Posterior pole field covering the optic disc and macula. Captured after pupil dilation: 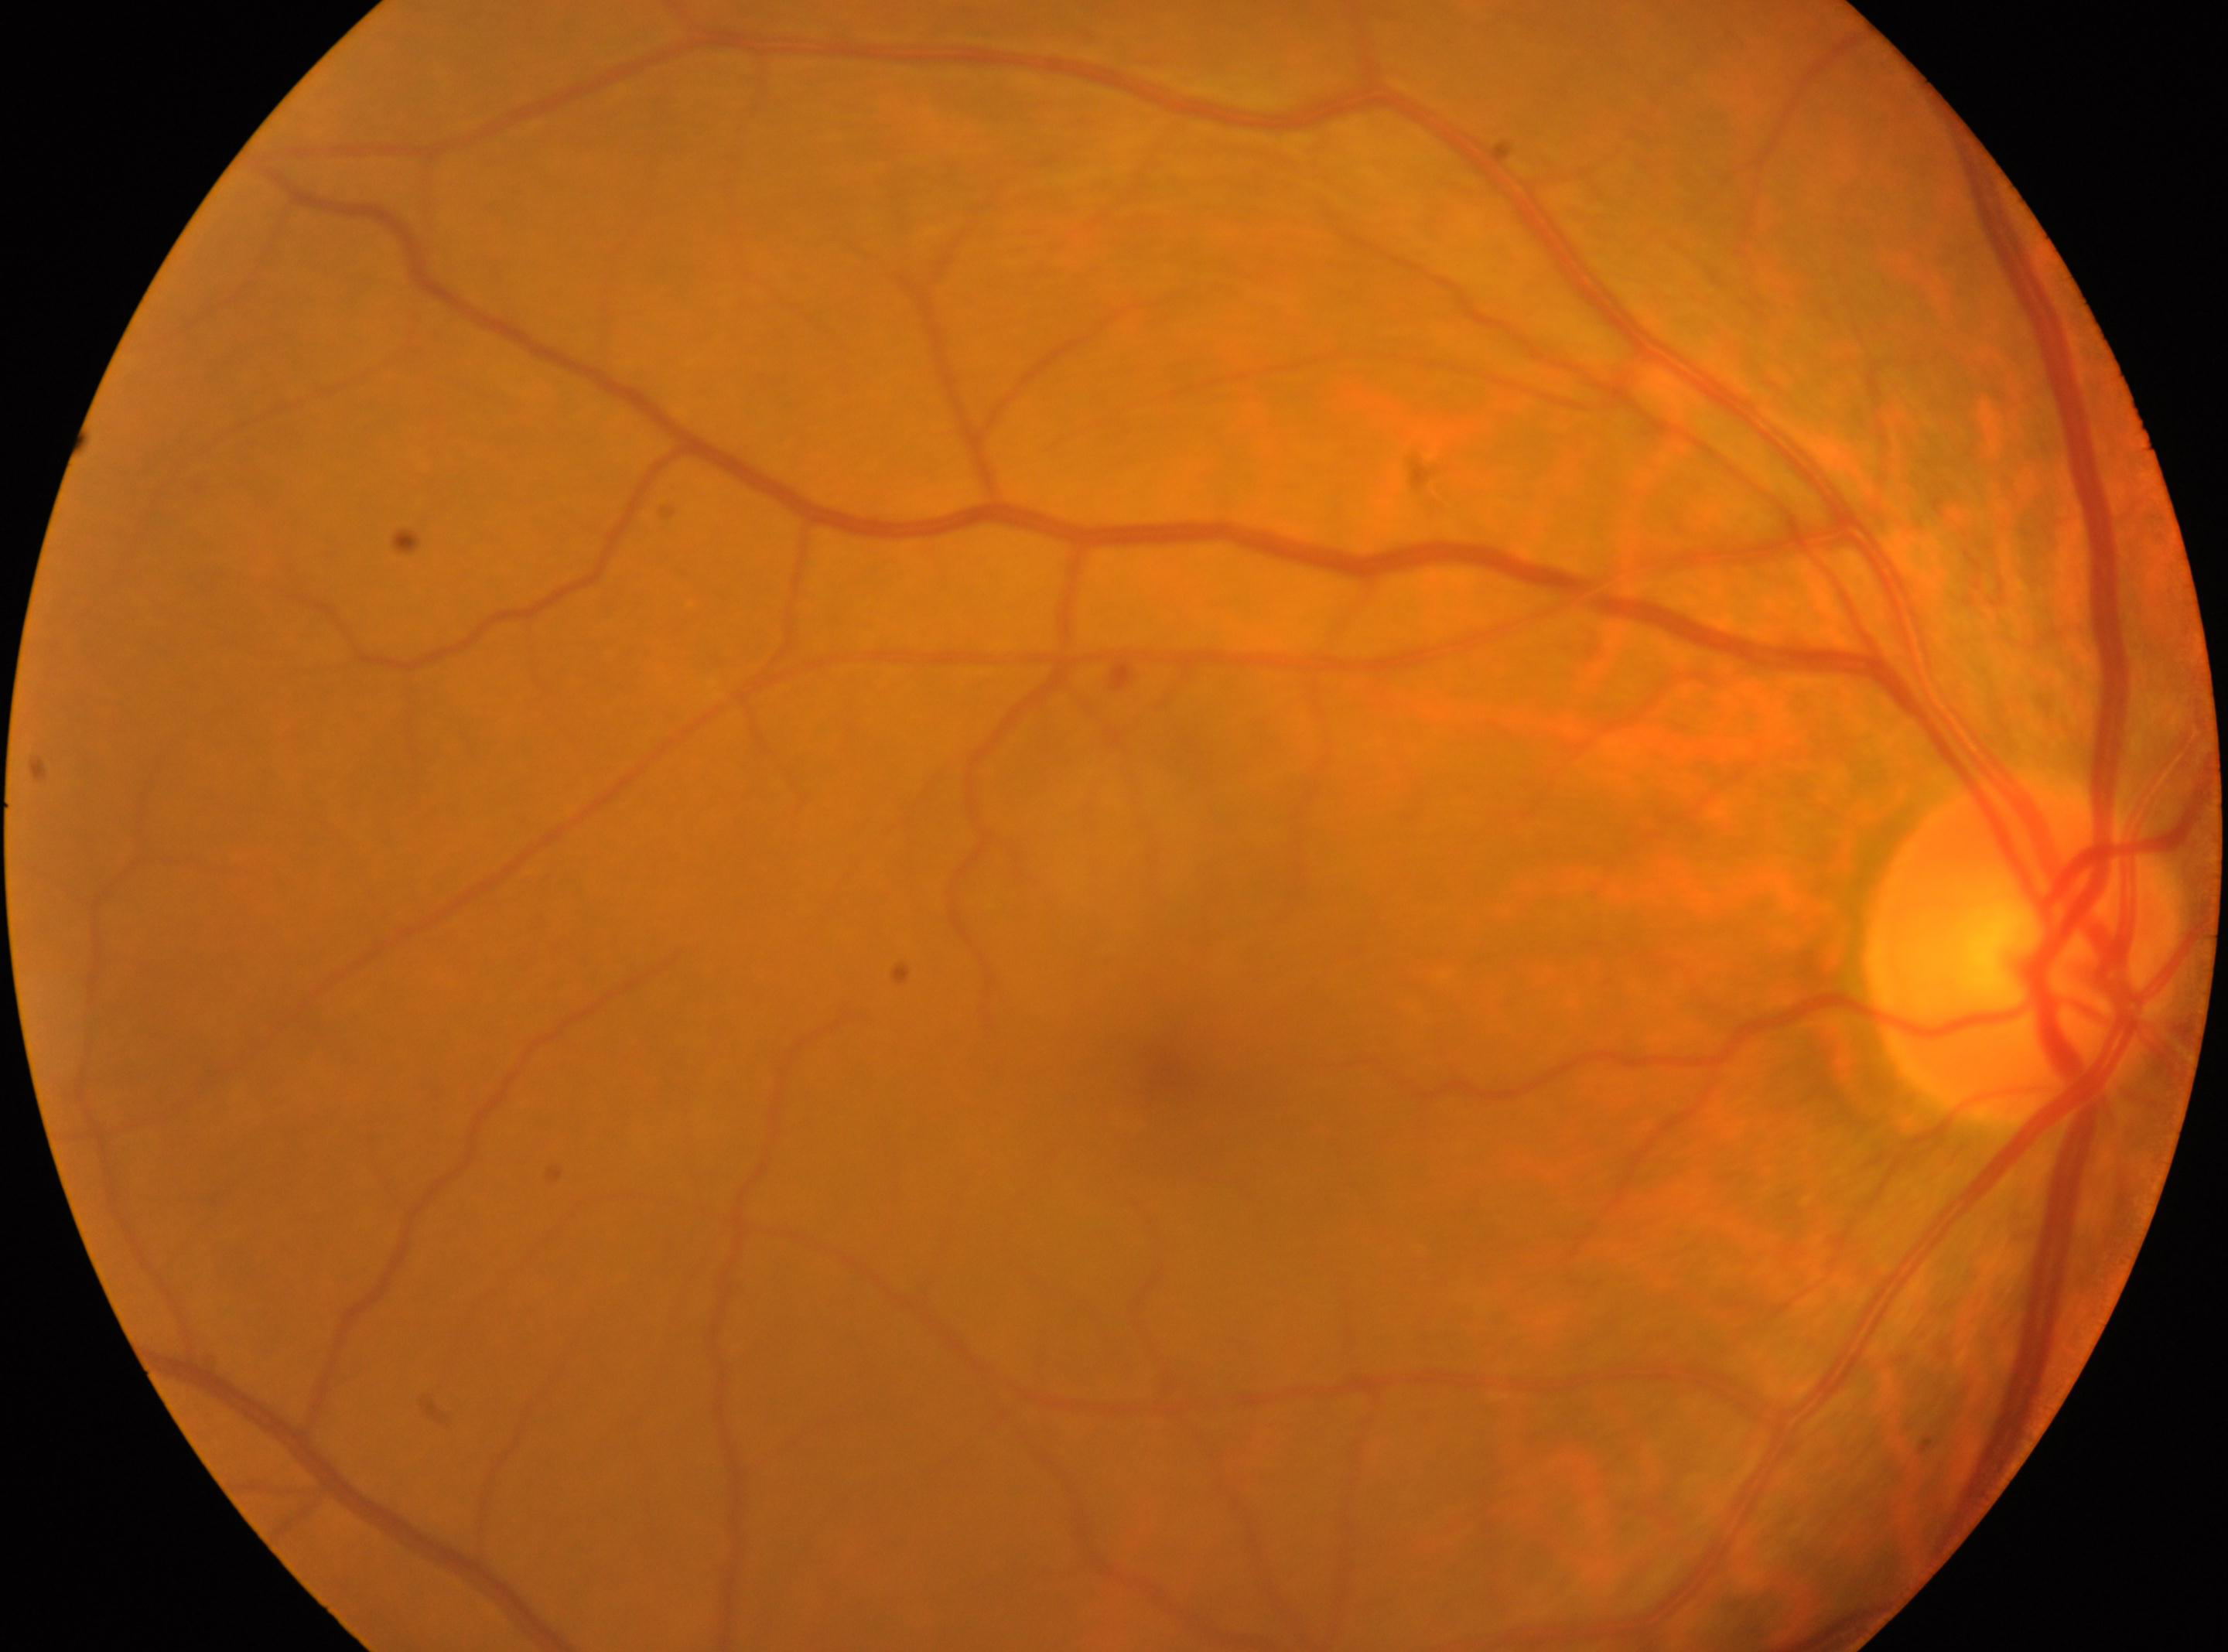
The image shows the right eye.
Diabetic retinopathy is 1.
Macula center located at (1174, 1081).
Optic nerve head: (2022, 948).